Infant wide-field retinal image; 100° field of view (Phoenix ICON) — 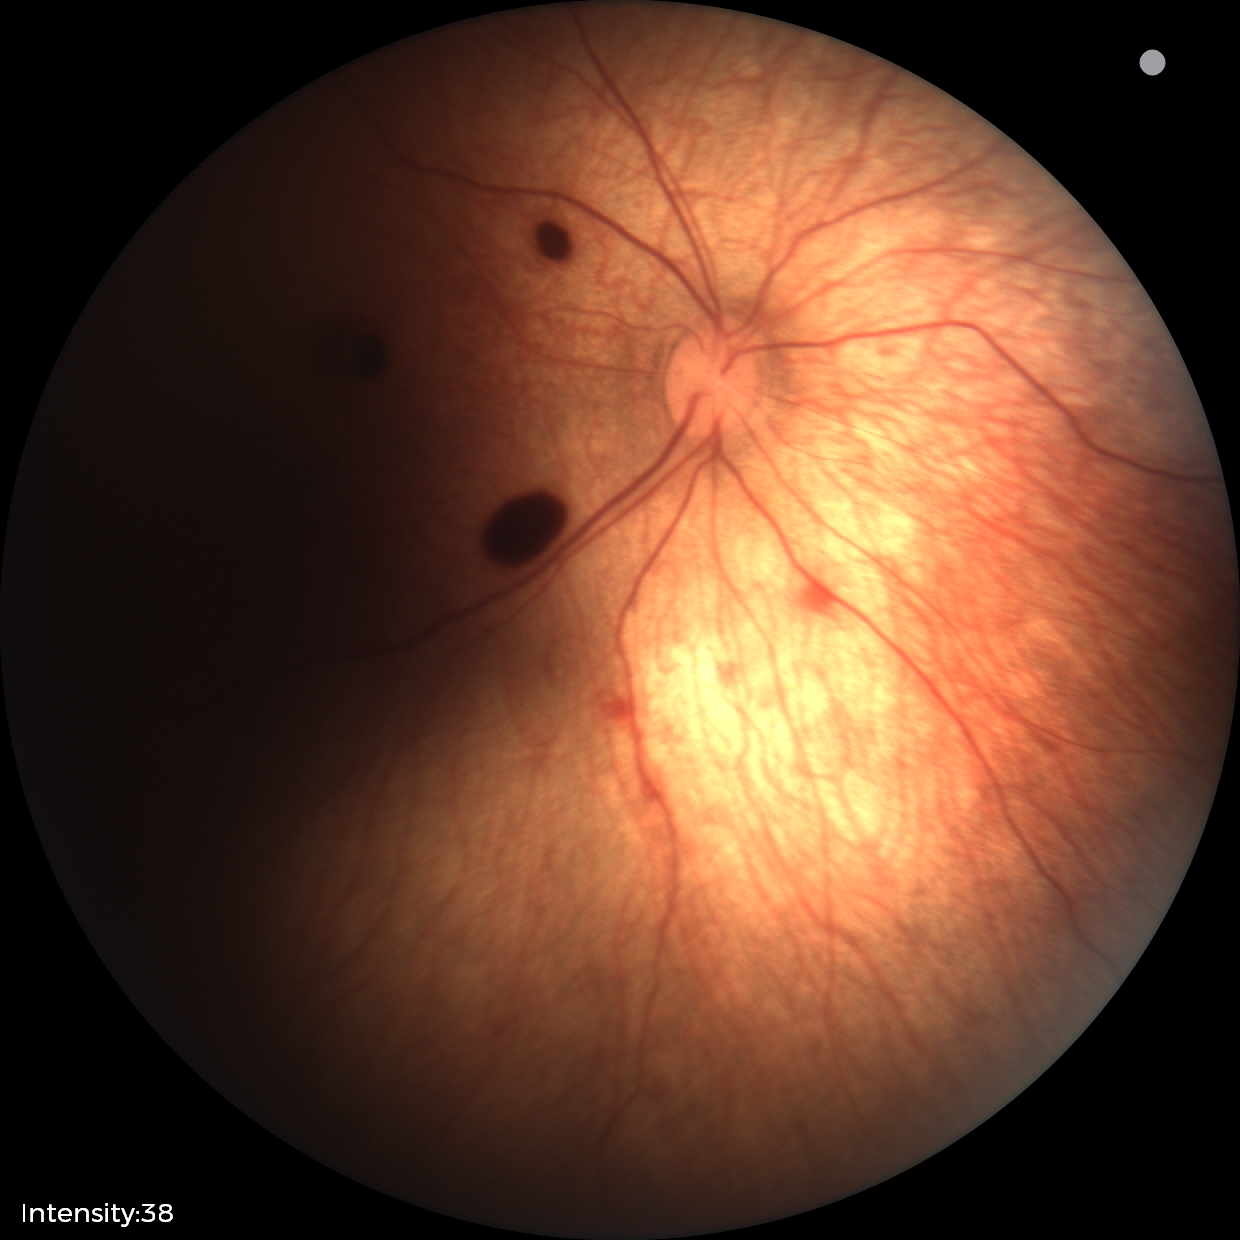 Diagnosis = retinal hemorrhages.